Nonmydriatic fundus photograph · fundus photo · acquired with a NIDEK AFC-230 · image size 848x848 — 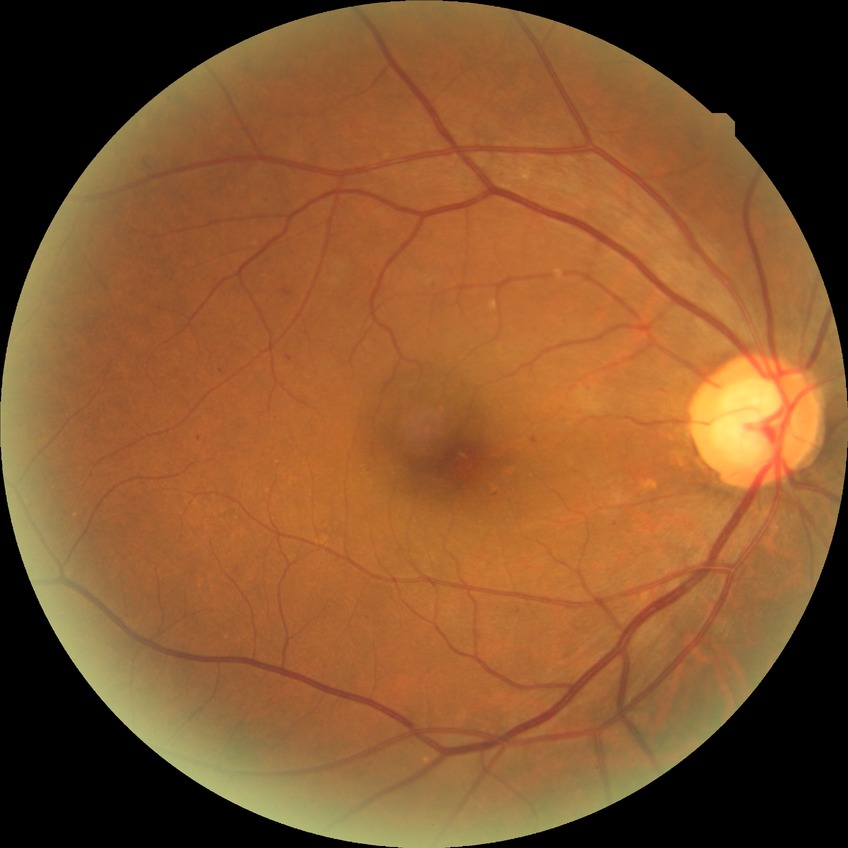
retinopathy stage = simple diabetic retinopathy
DR class = non-proliferative diabetic retinopathy